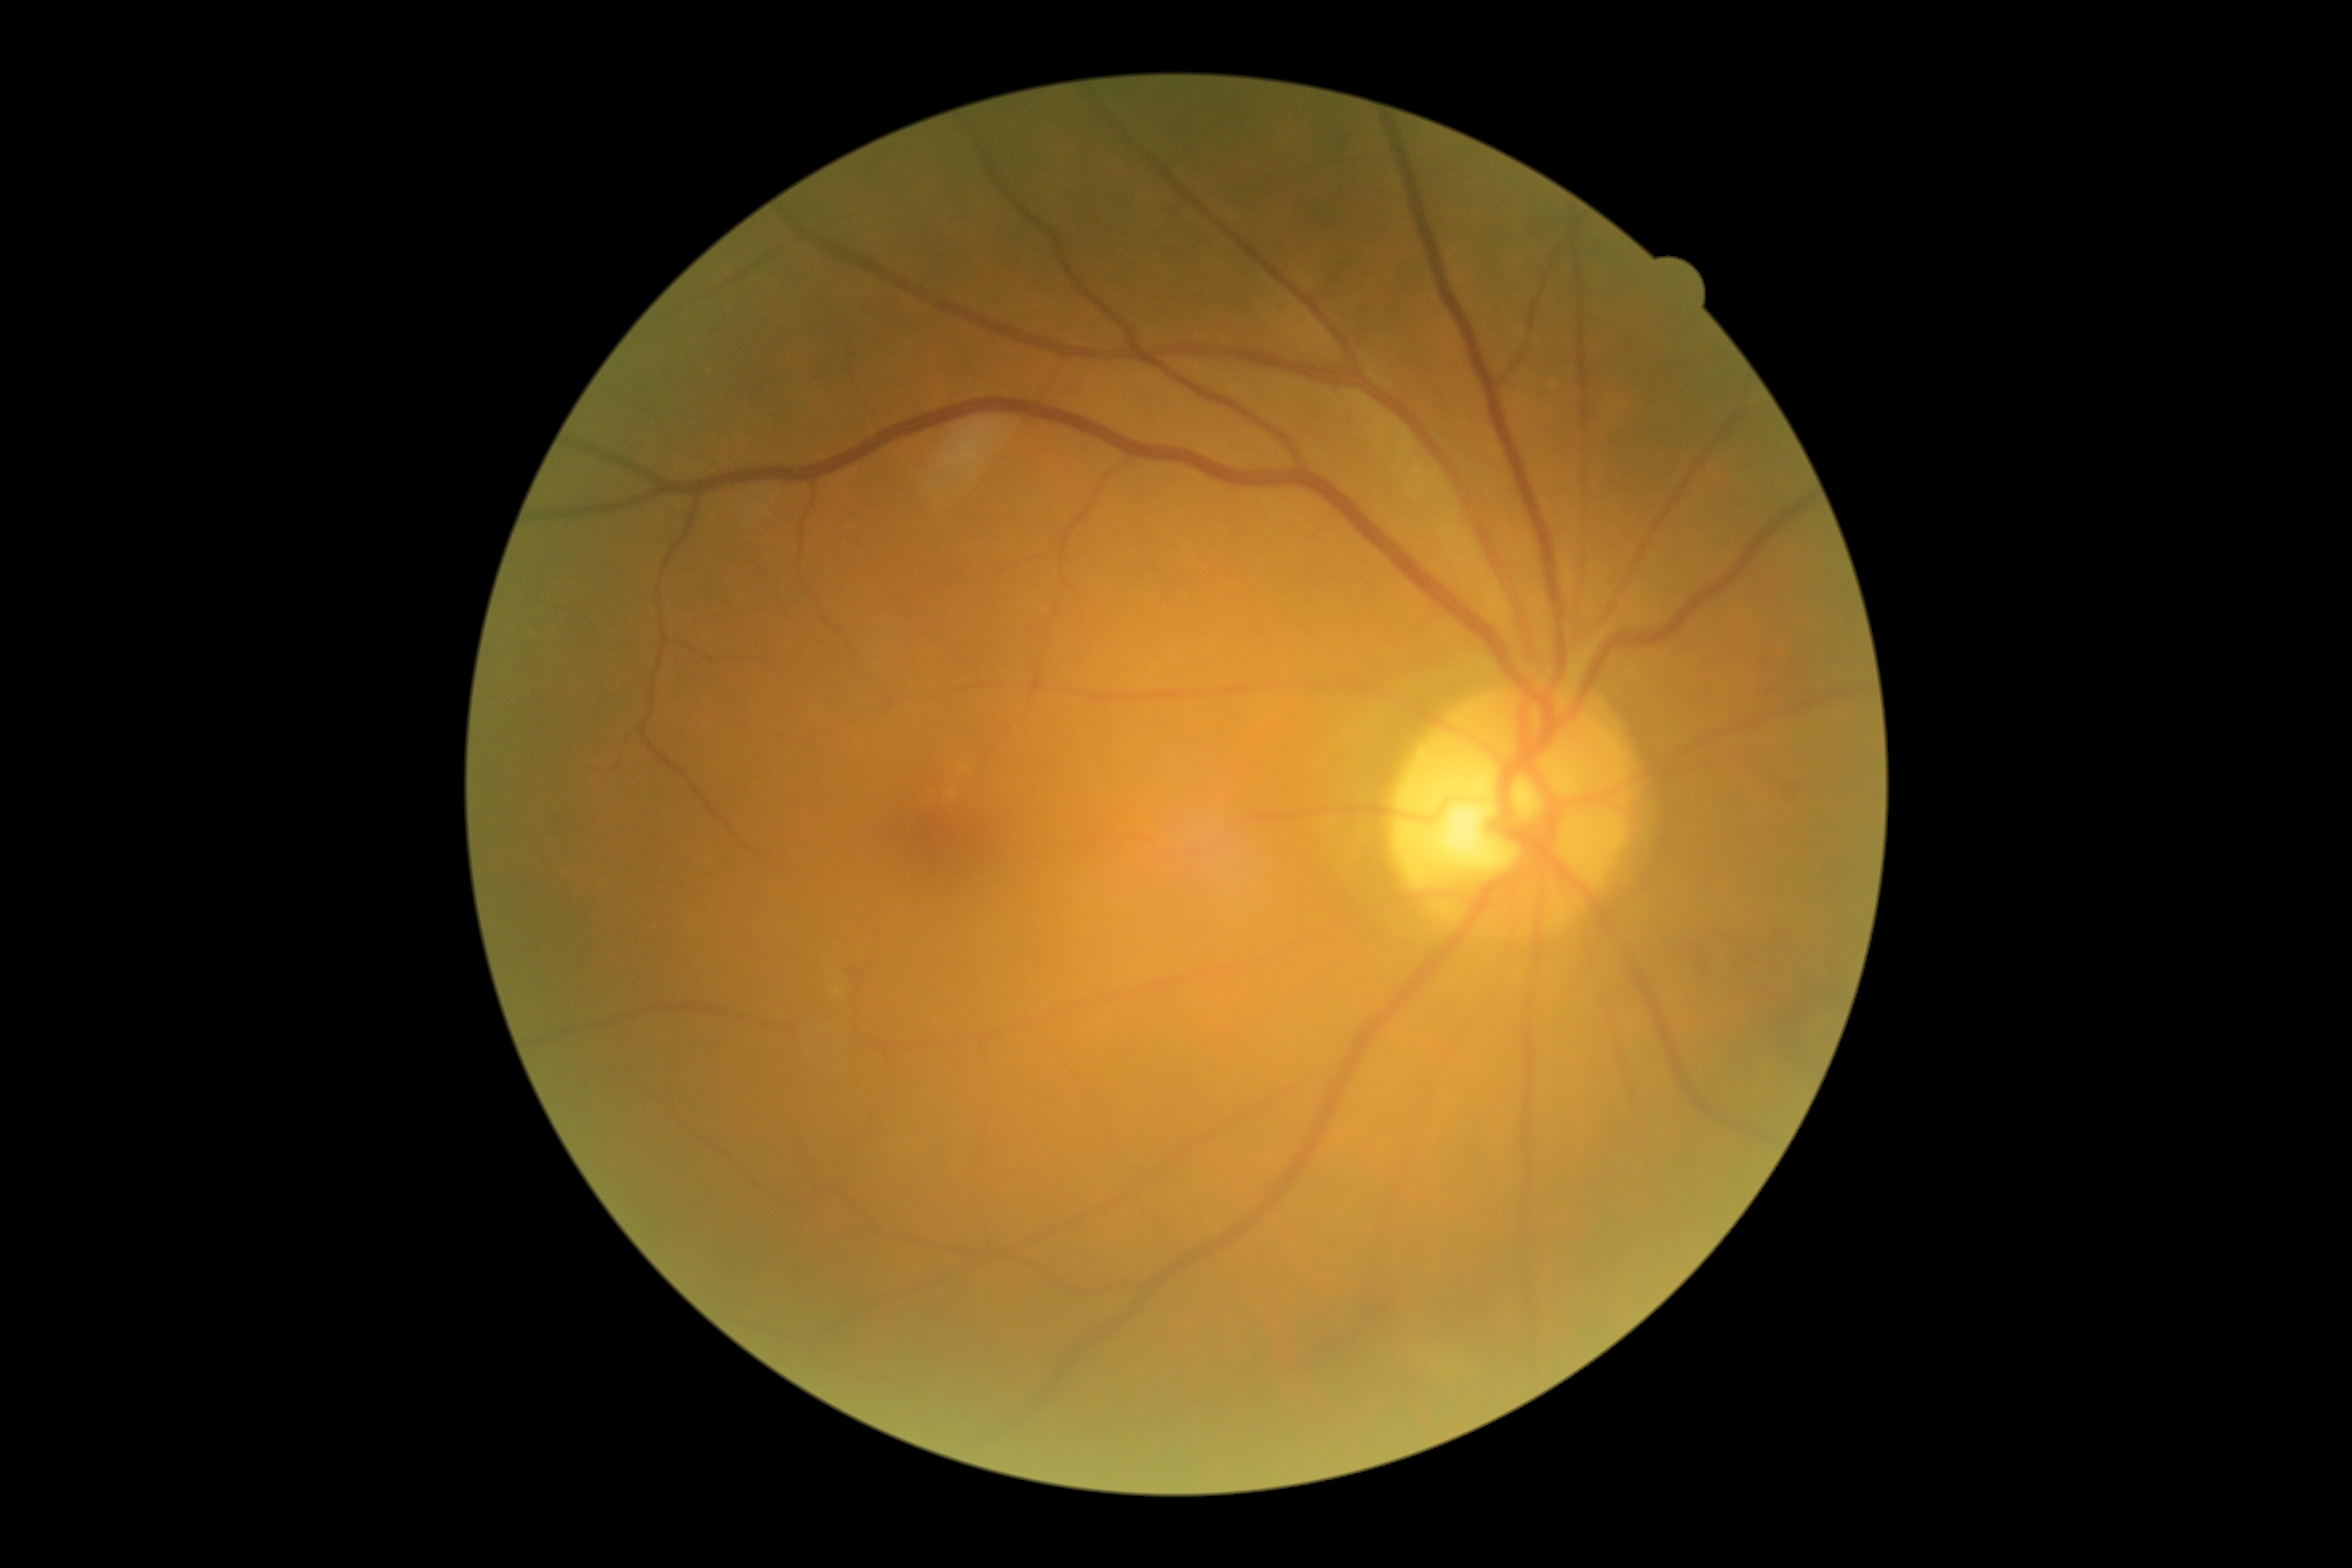
Retinopathy grade: 2 (moderate NPDR) — more than just microaneurysms but less than severe NPDR.
The retinopathy is classified as non-proliferative diabetic retinopathy.